Pediatric wide-field fundus photograph; 1240 by 1240 pixels.
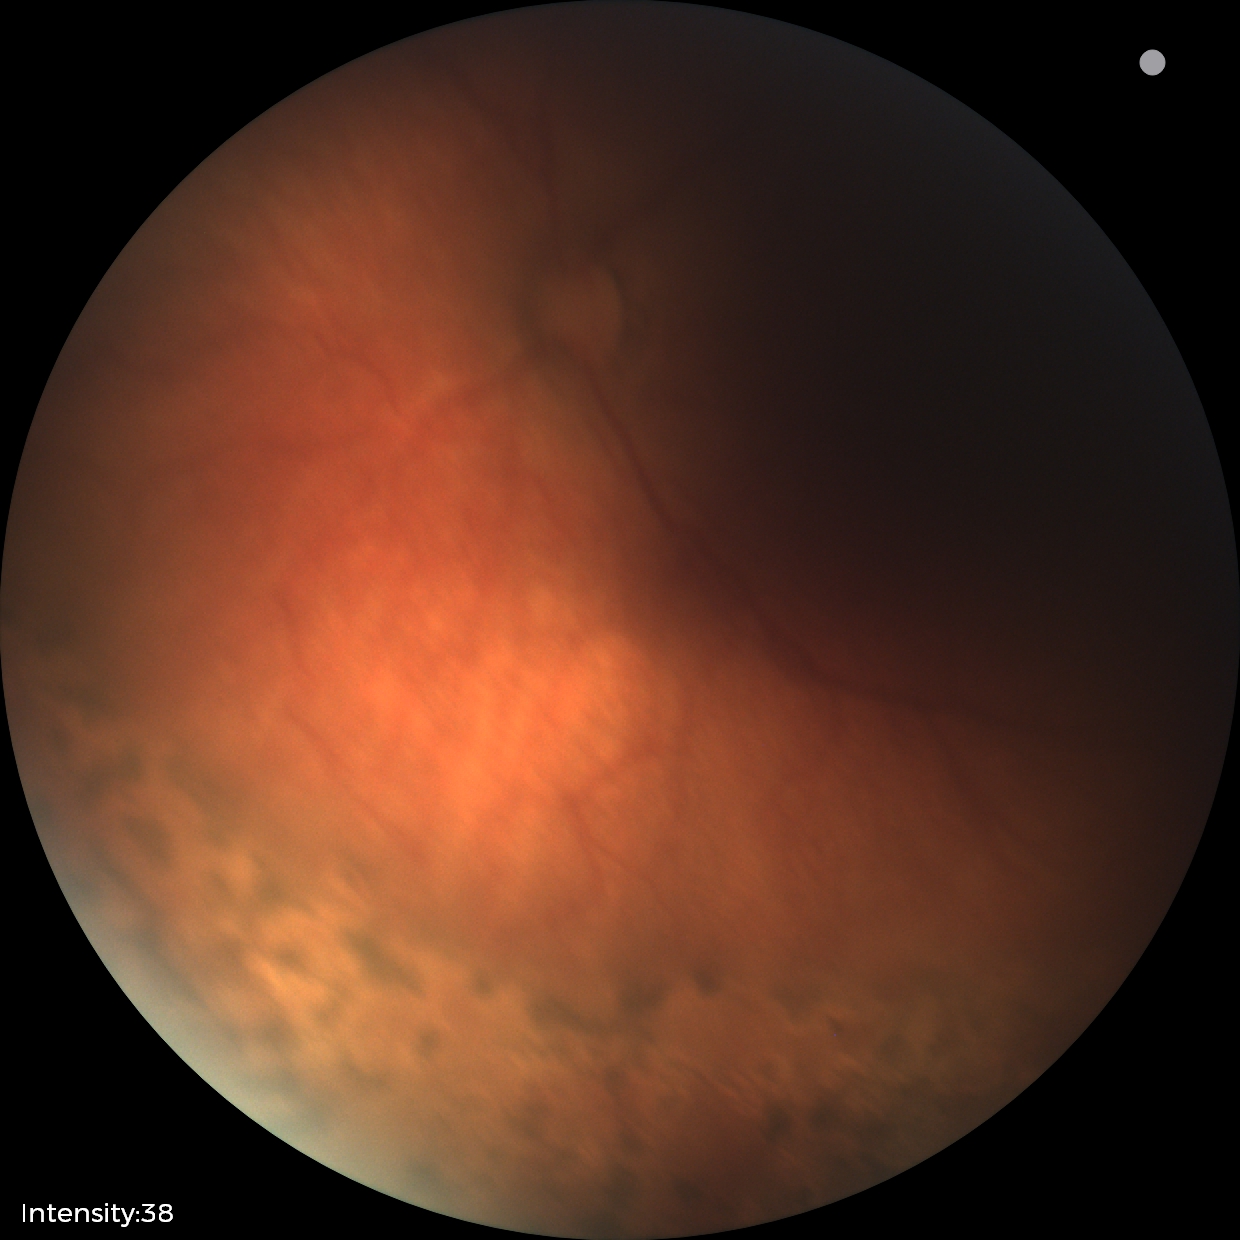
Screening diagnosis: no plus disease | status post retinopathy of prematurity — retinal appearance after treated retinopathy of prematurity.